Wide-field fundus photograph of an infant
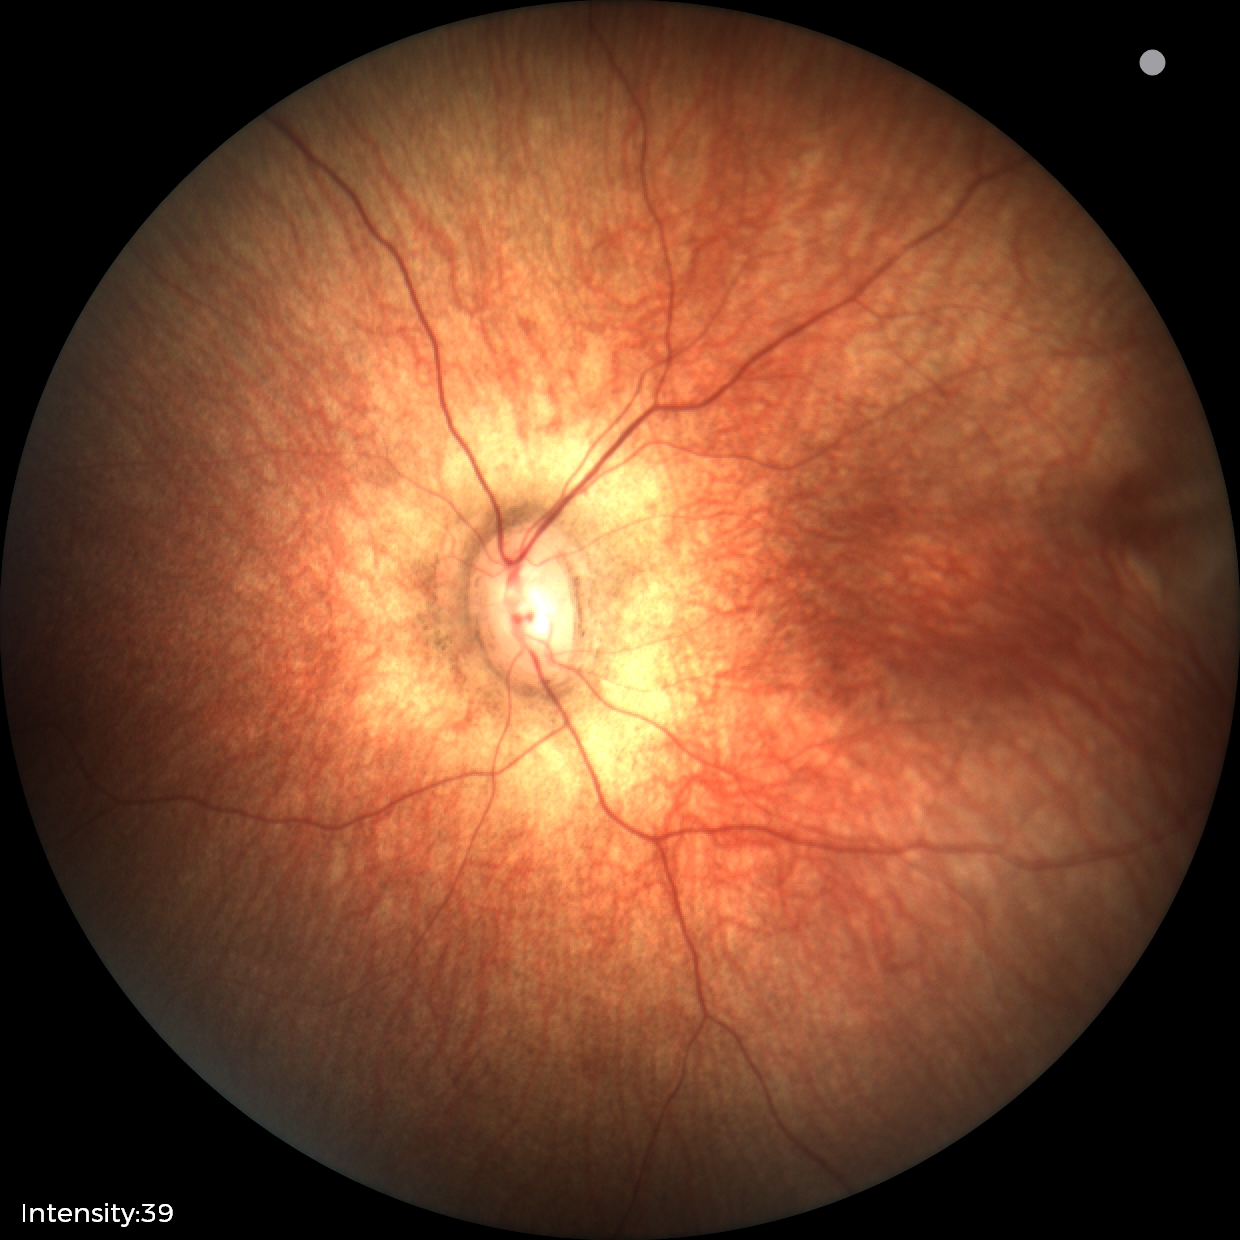 Physiological retinal appearance for postconceptual age.